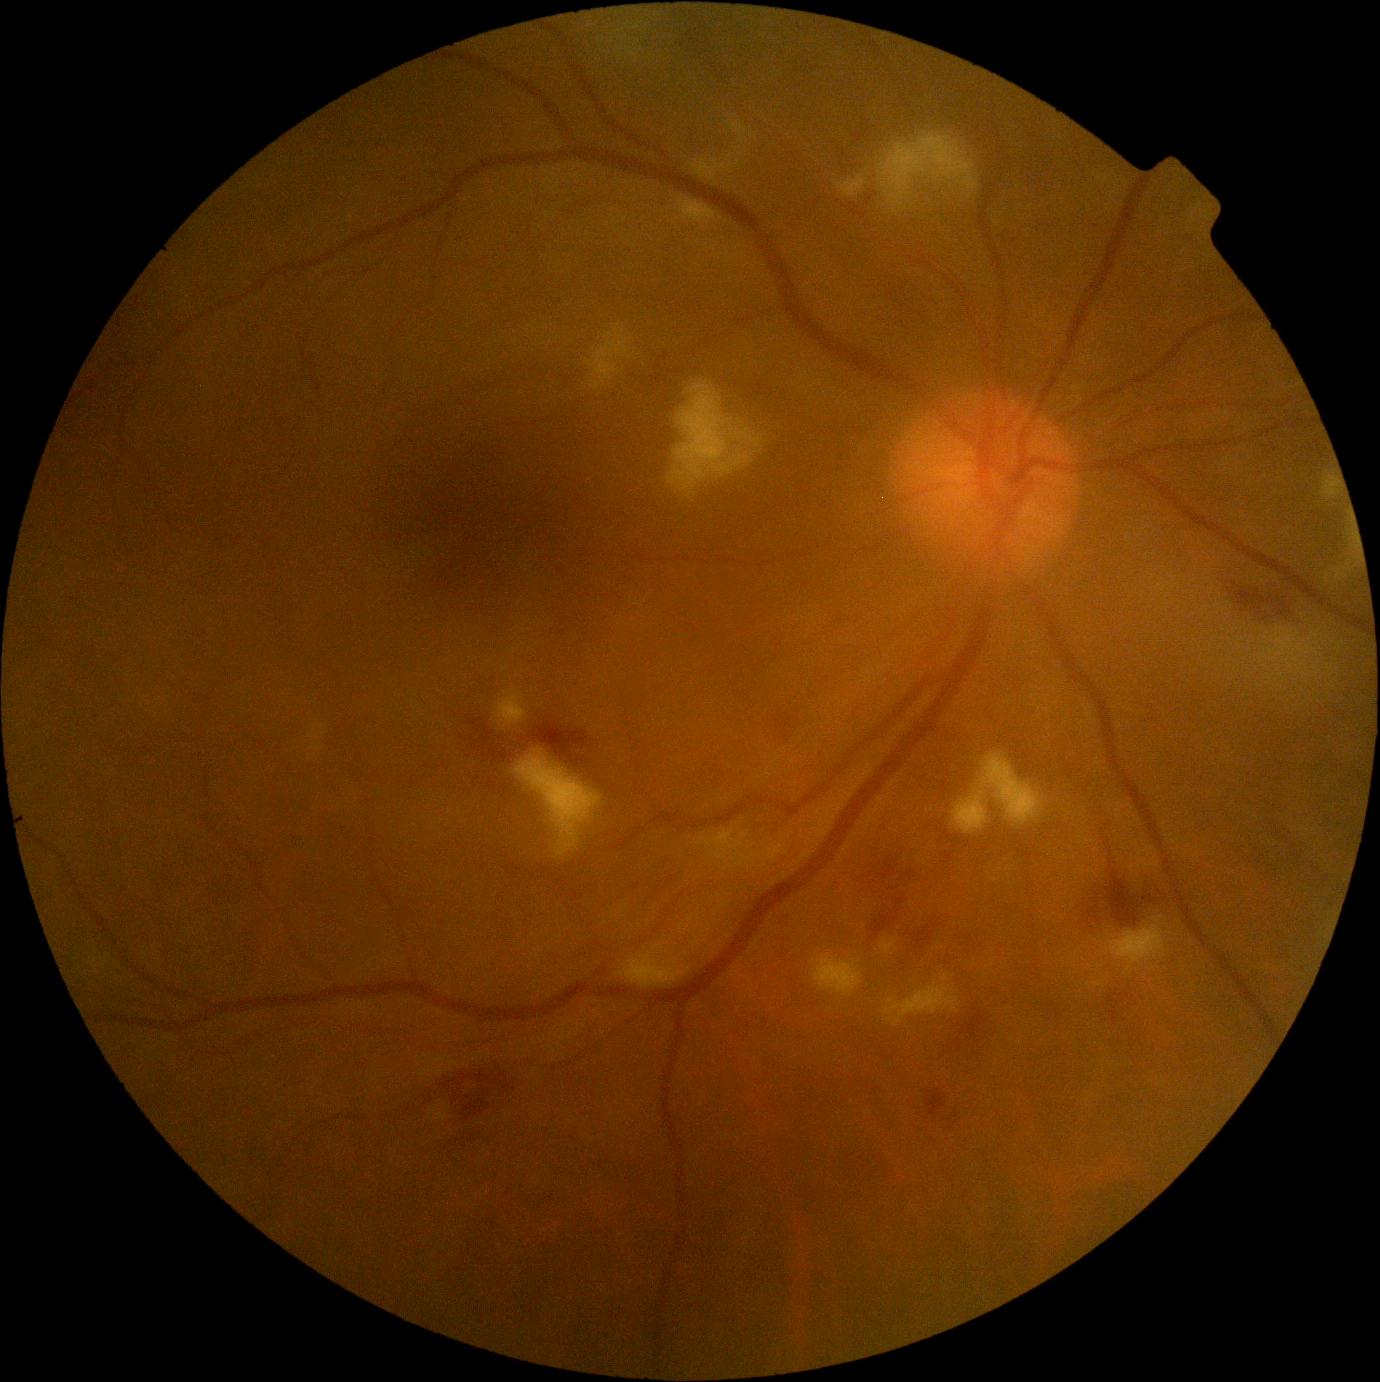

The retinopathy is classified as non-proliferative diabetic retinopathy.
Diabetic retinopathy grade: 2 (moderate NPDR) — more than just microaneurysms but less than severe NPDR.